Without pupil dilation · NIDEK AFC-230 fundus camera · 848 by 848 pixels · 45° FOV
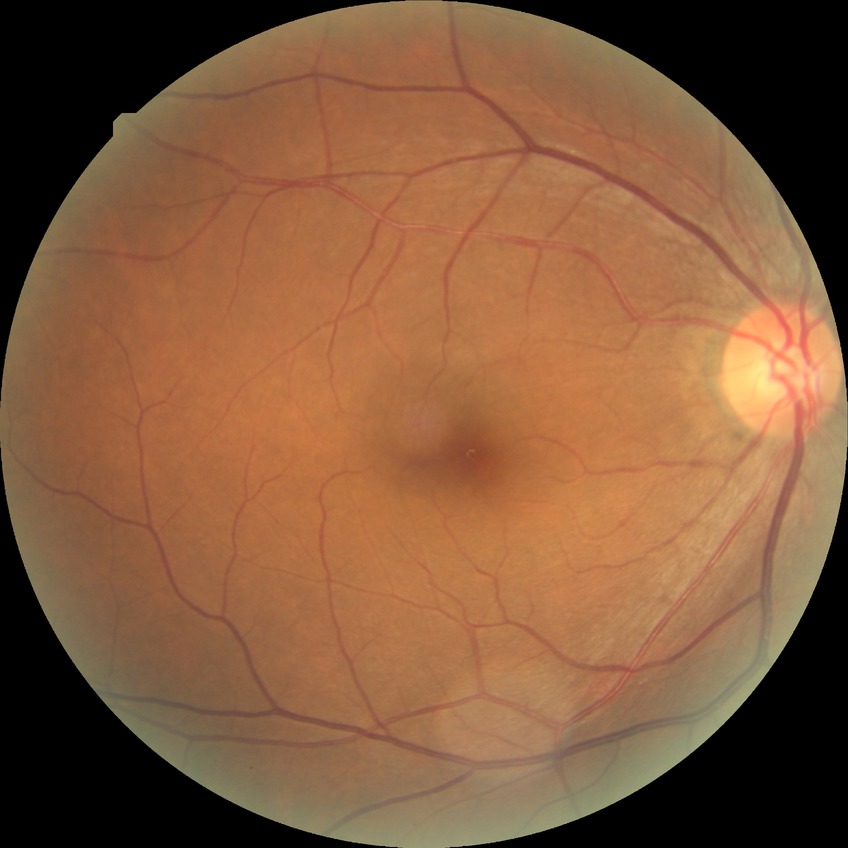

{"davis_grade": "no diabetic retinopathy"}